Color fundus image: 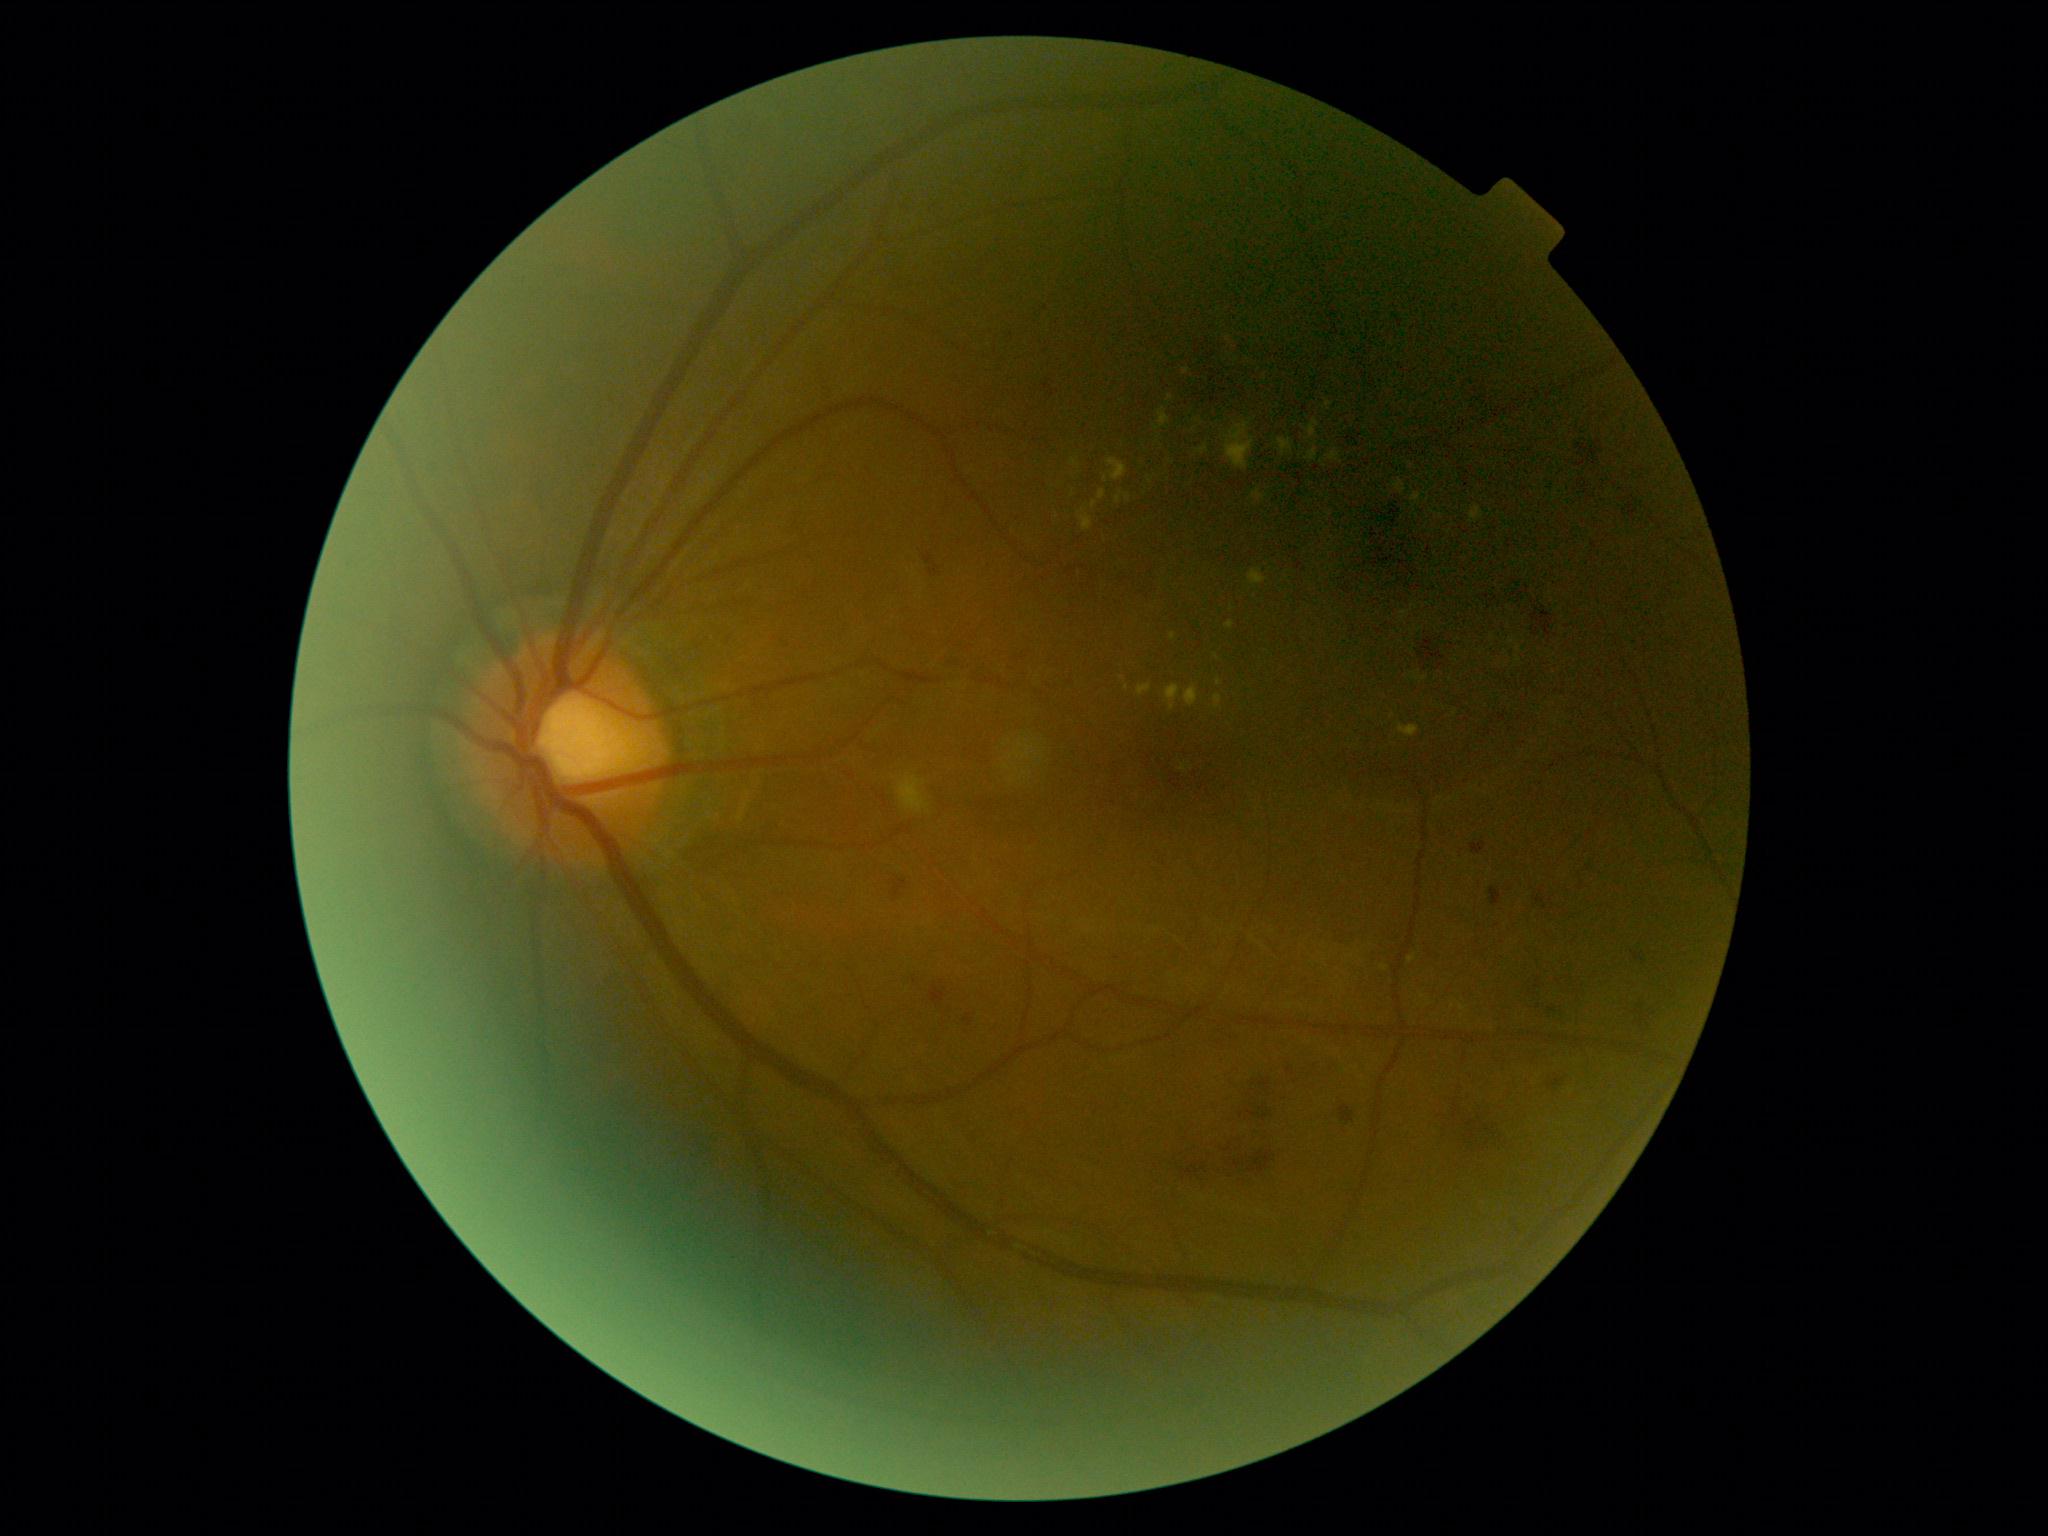
  dr_grade: 2 (moderate NPDR)